2352x1568px: 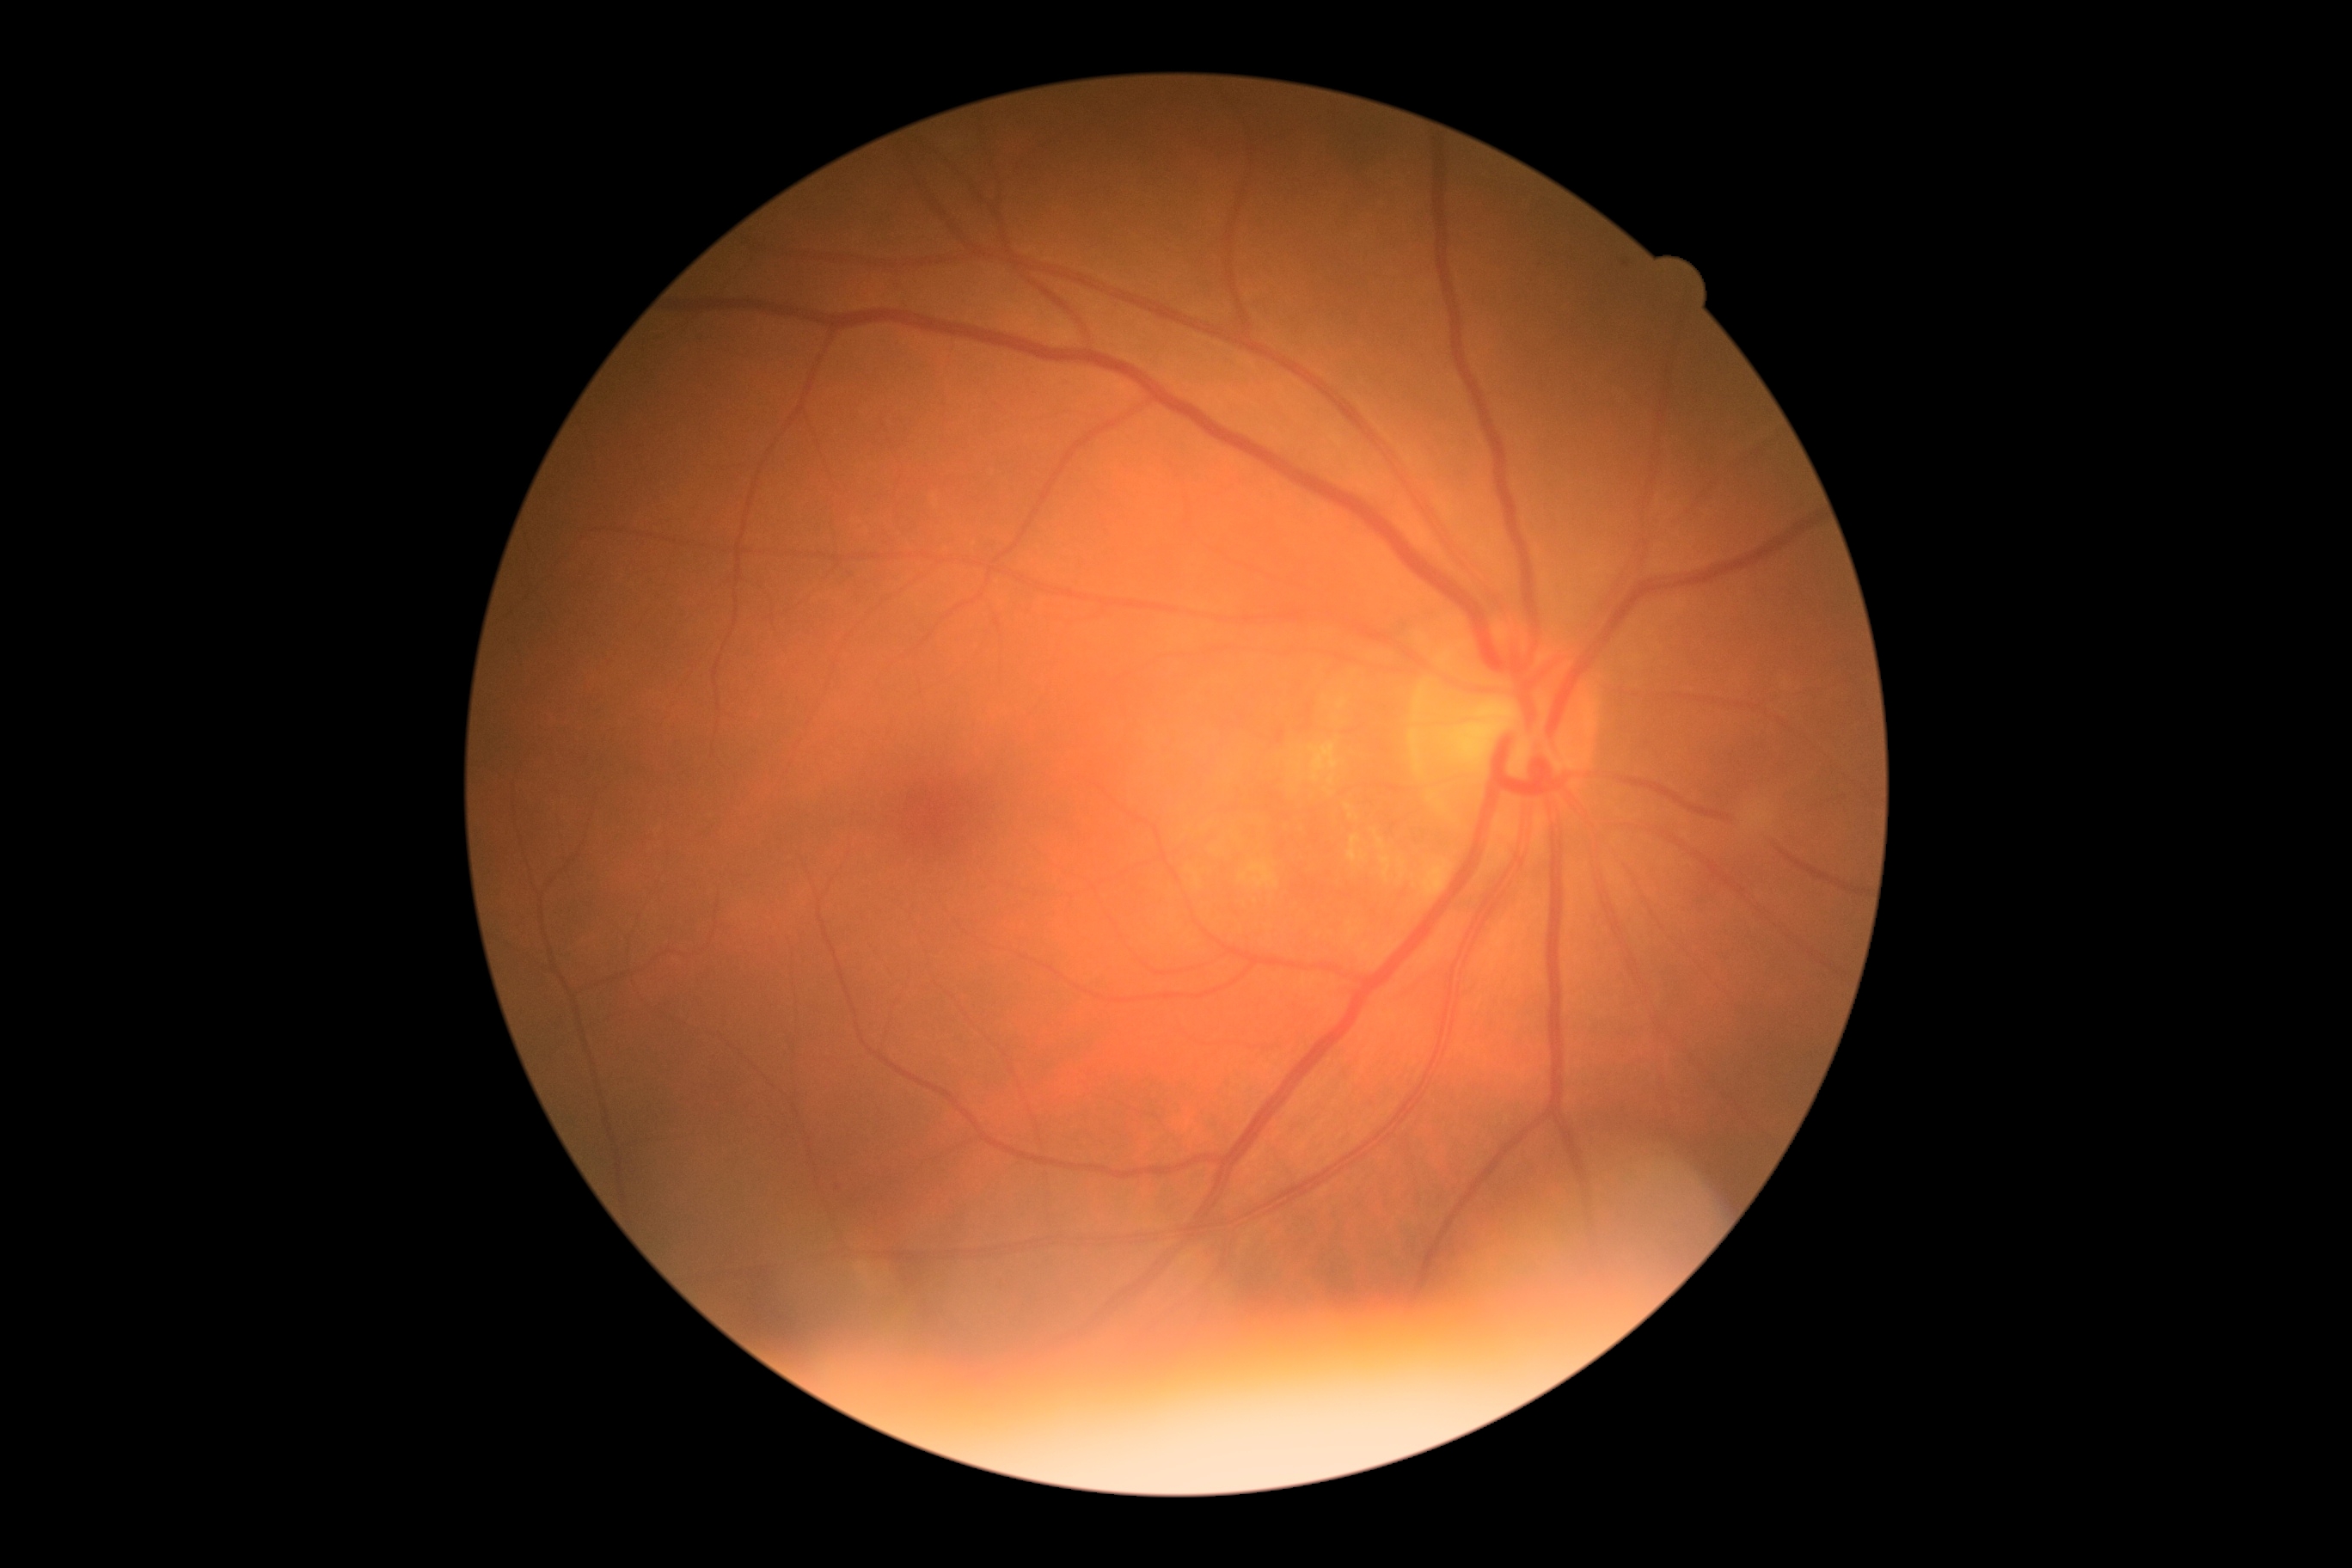 DR grade: 1/4 — presence of microaneurysms only.